Color fundus photograph; NIDEK AFC-230
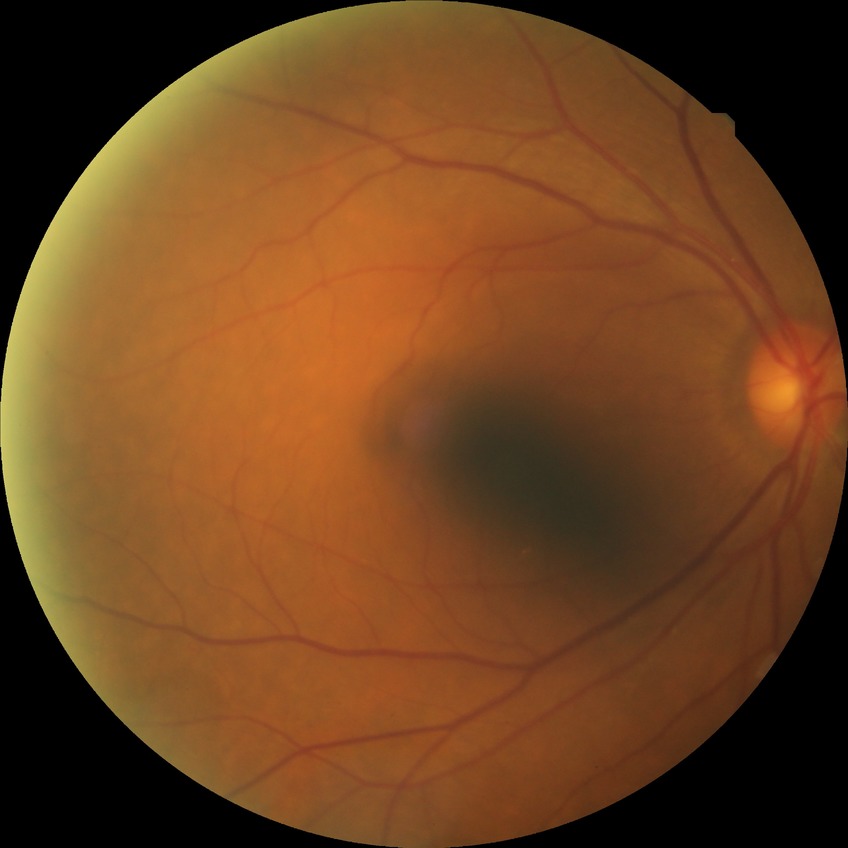
diabetic retinopathy (DR)=simple diabetic retinopathy (SDR).